FOV: 200 degrees. Ultra-widefield fundus mosaic:
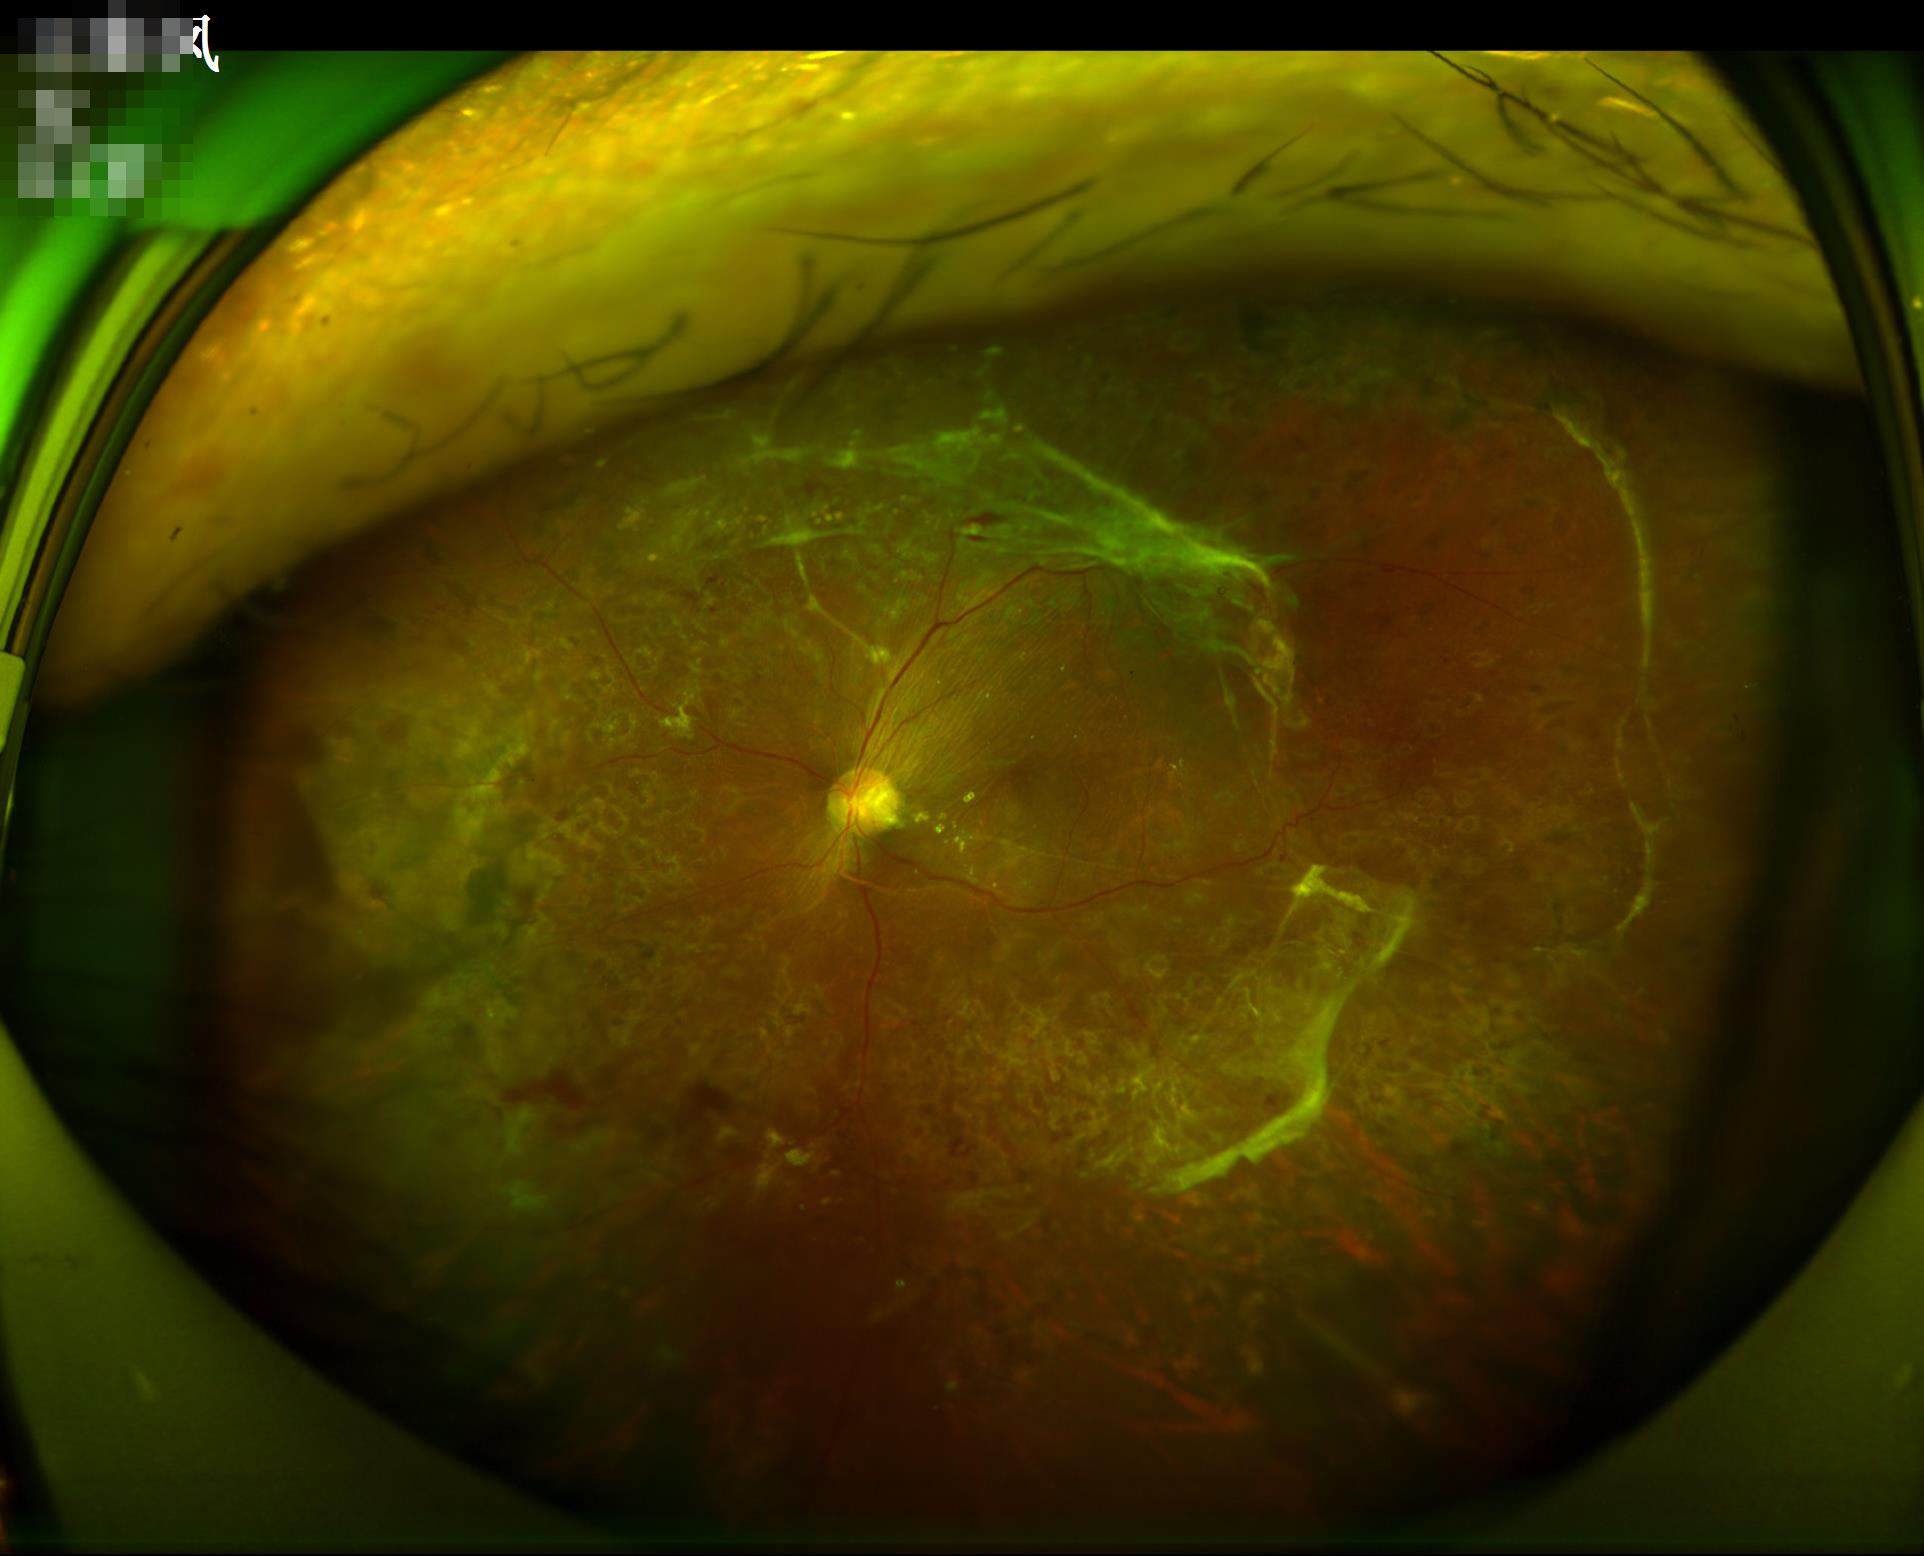 Sharpness = sharp; Overall = adequate; Illumination = even.